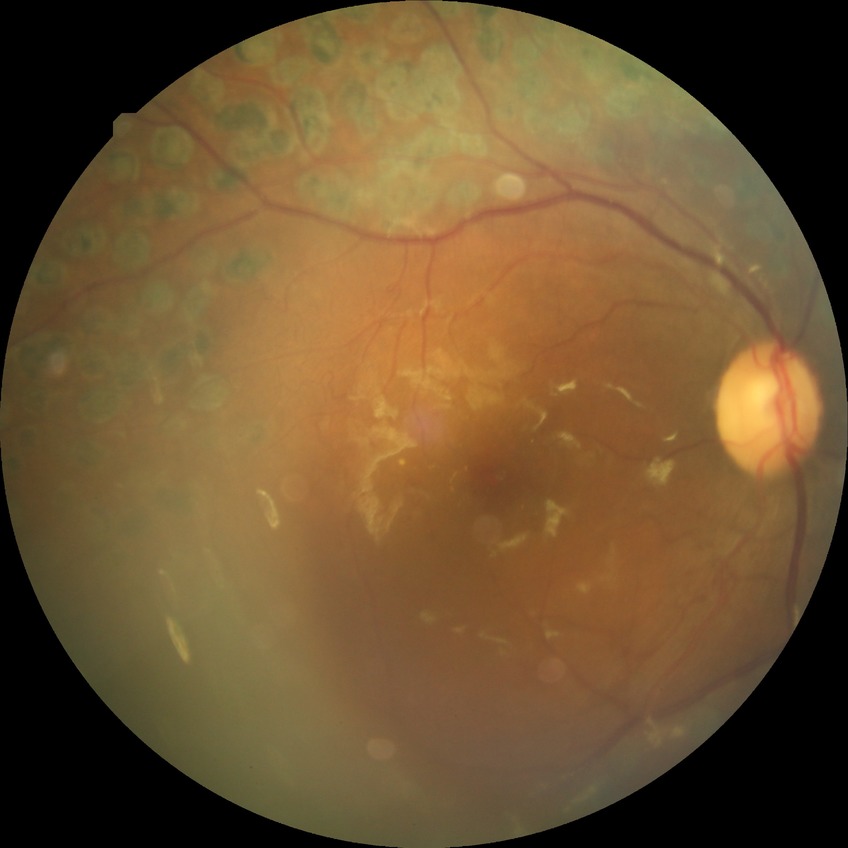
diabetic retinopathy stage=proliferative diabetic retinopathy.